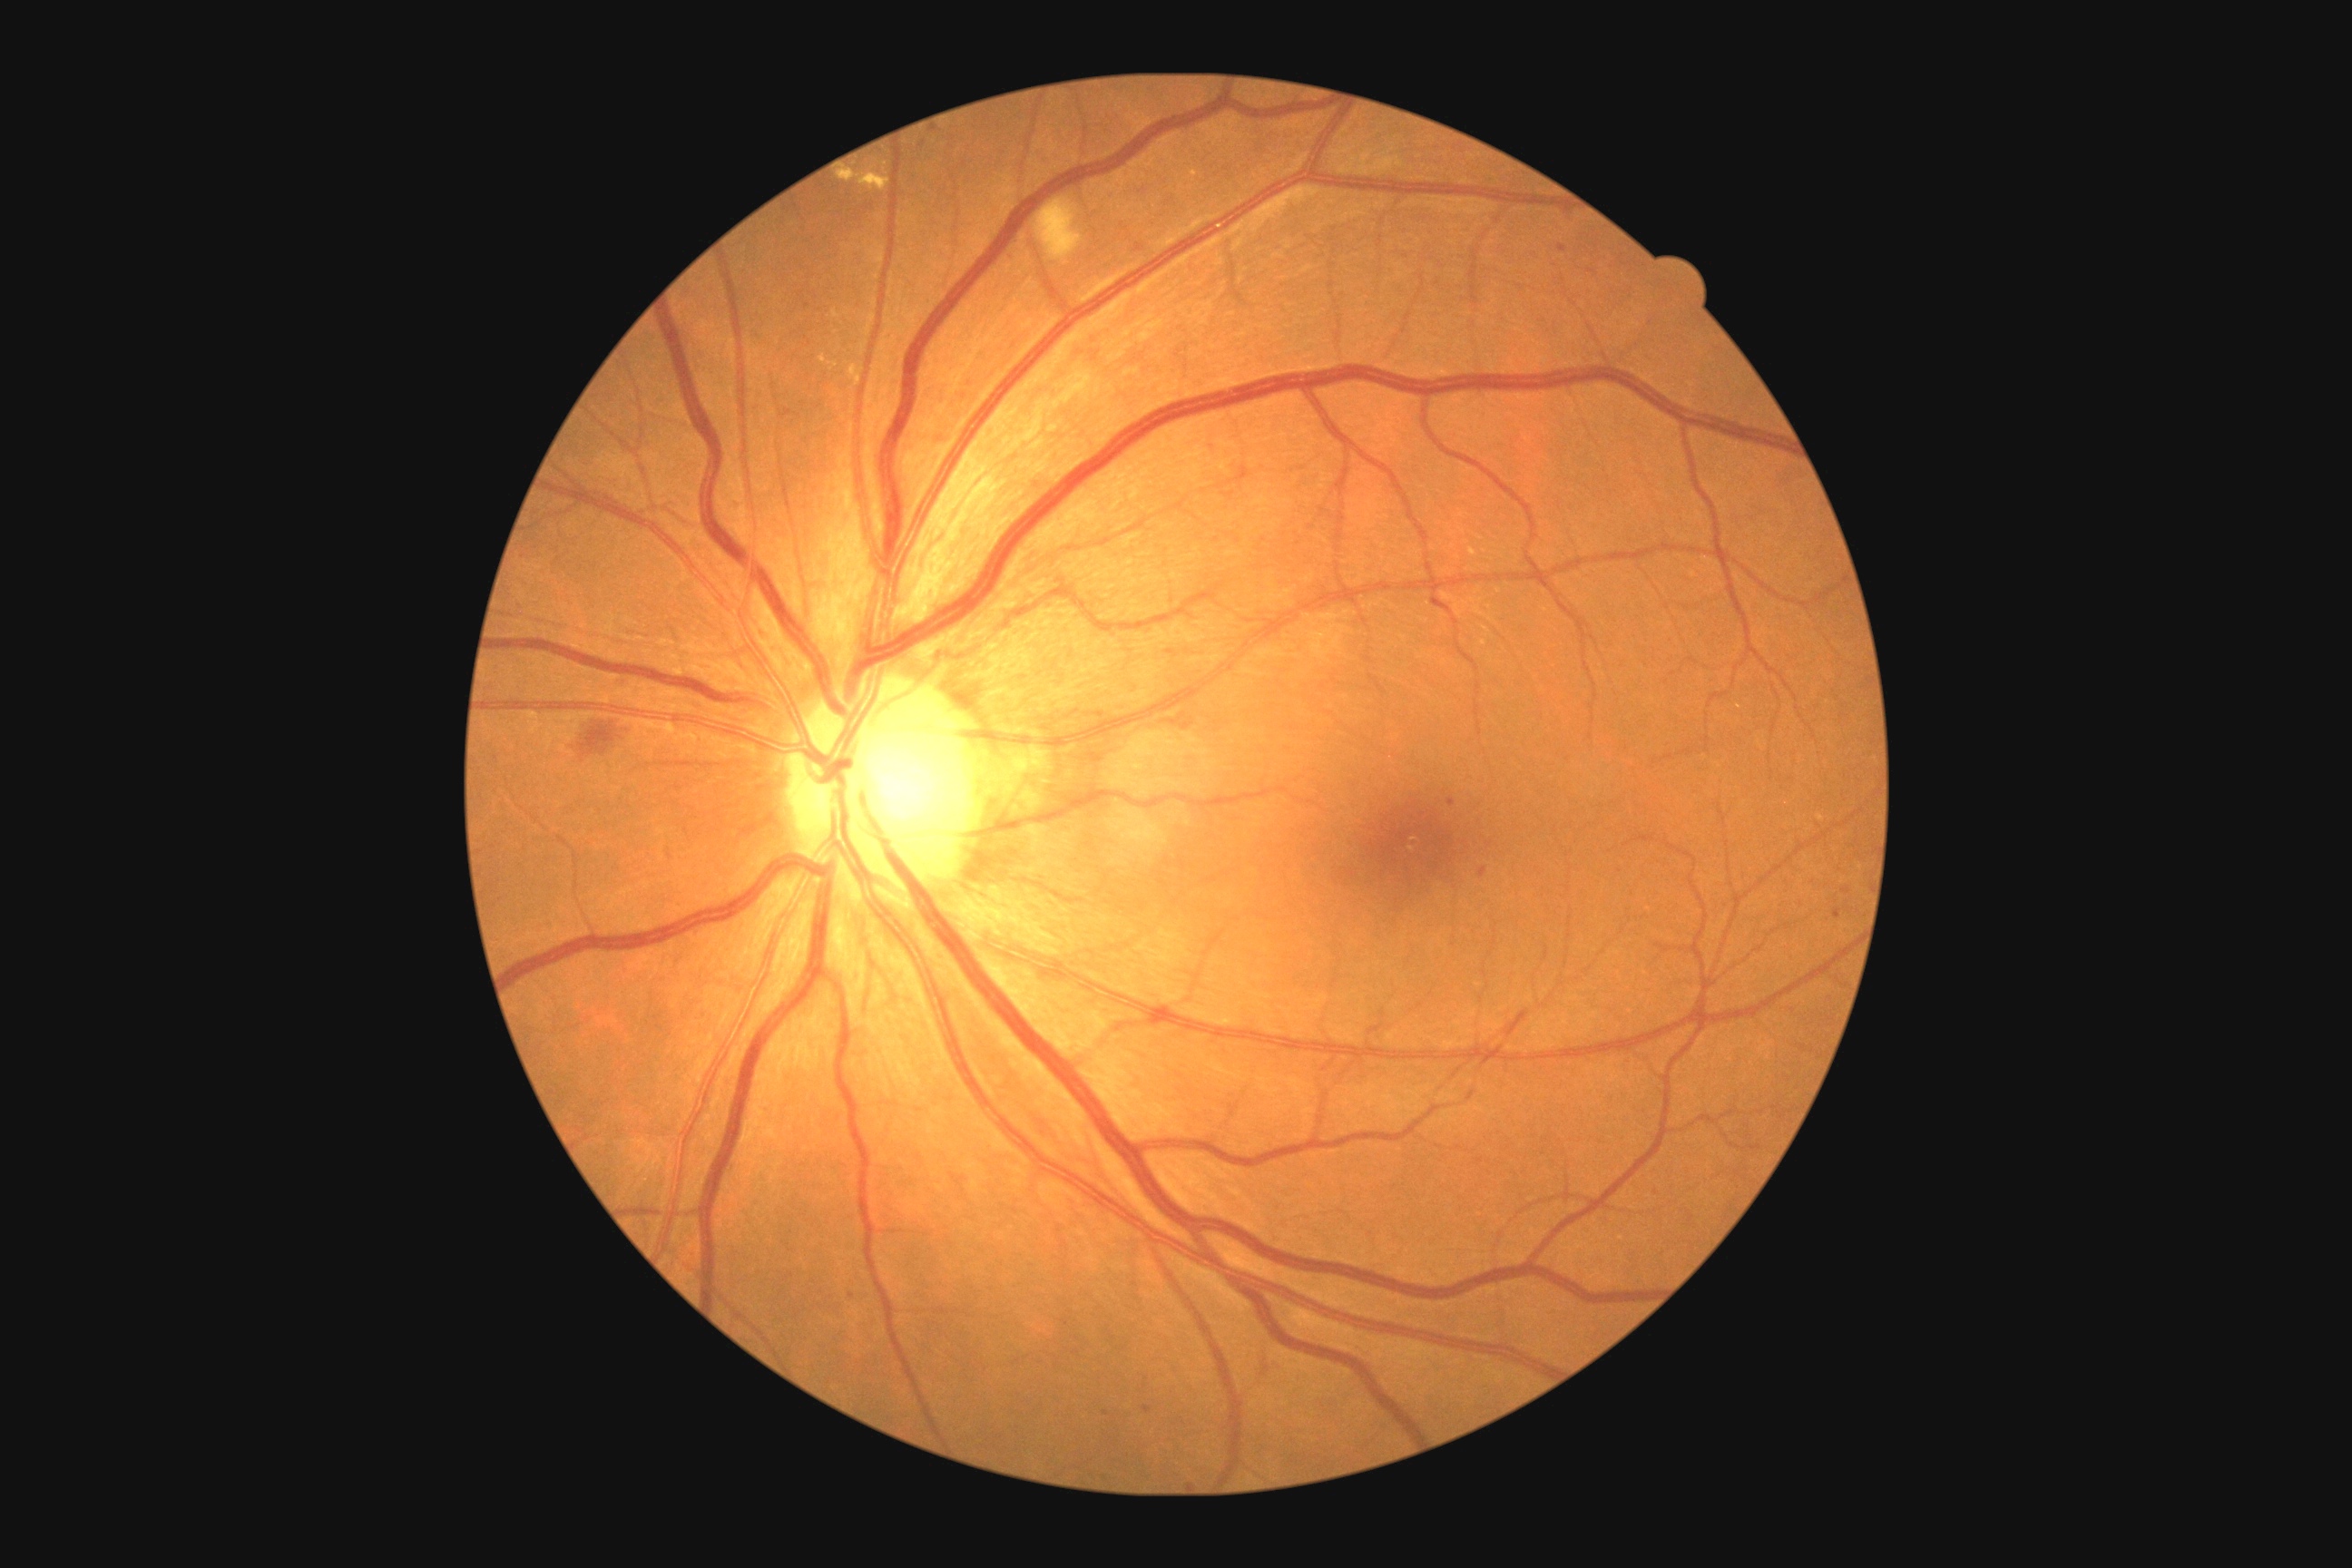

{"dr_grade": "2 — more than just microaneurysms but less than severe NPDR"}